Color fundus image: 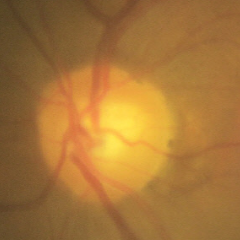
Assessment = no glaucomatous findings.